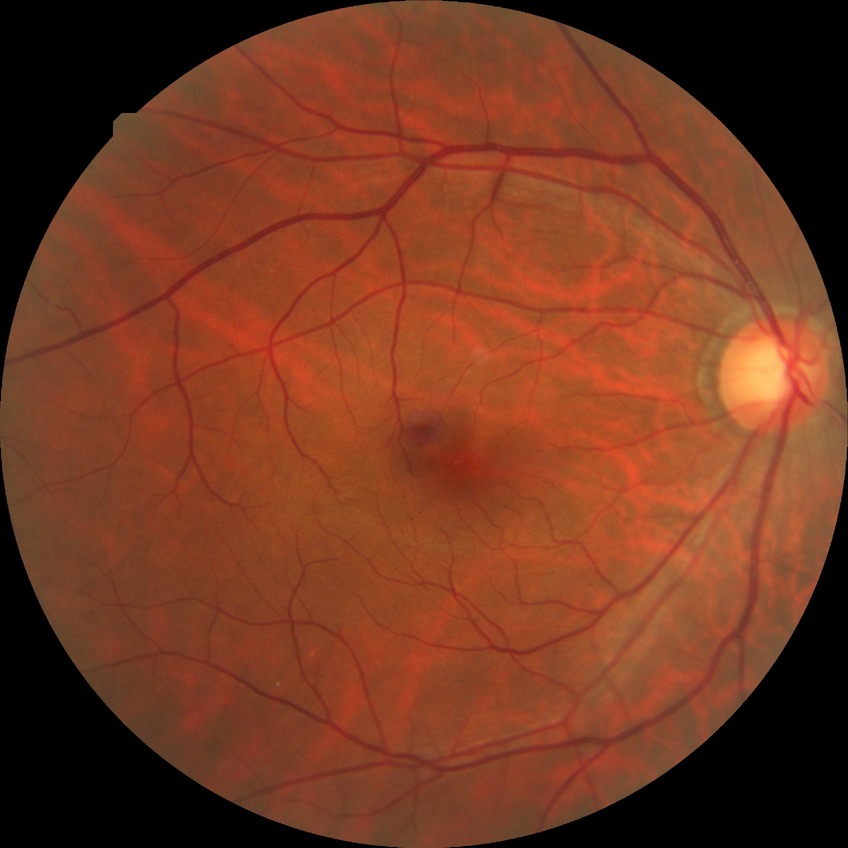

davis_grade: no diabetic retinopathy (NDR)